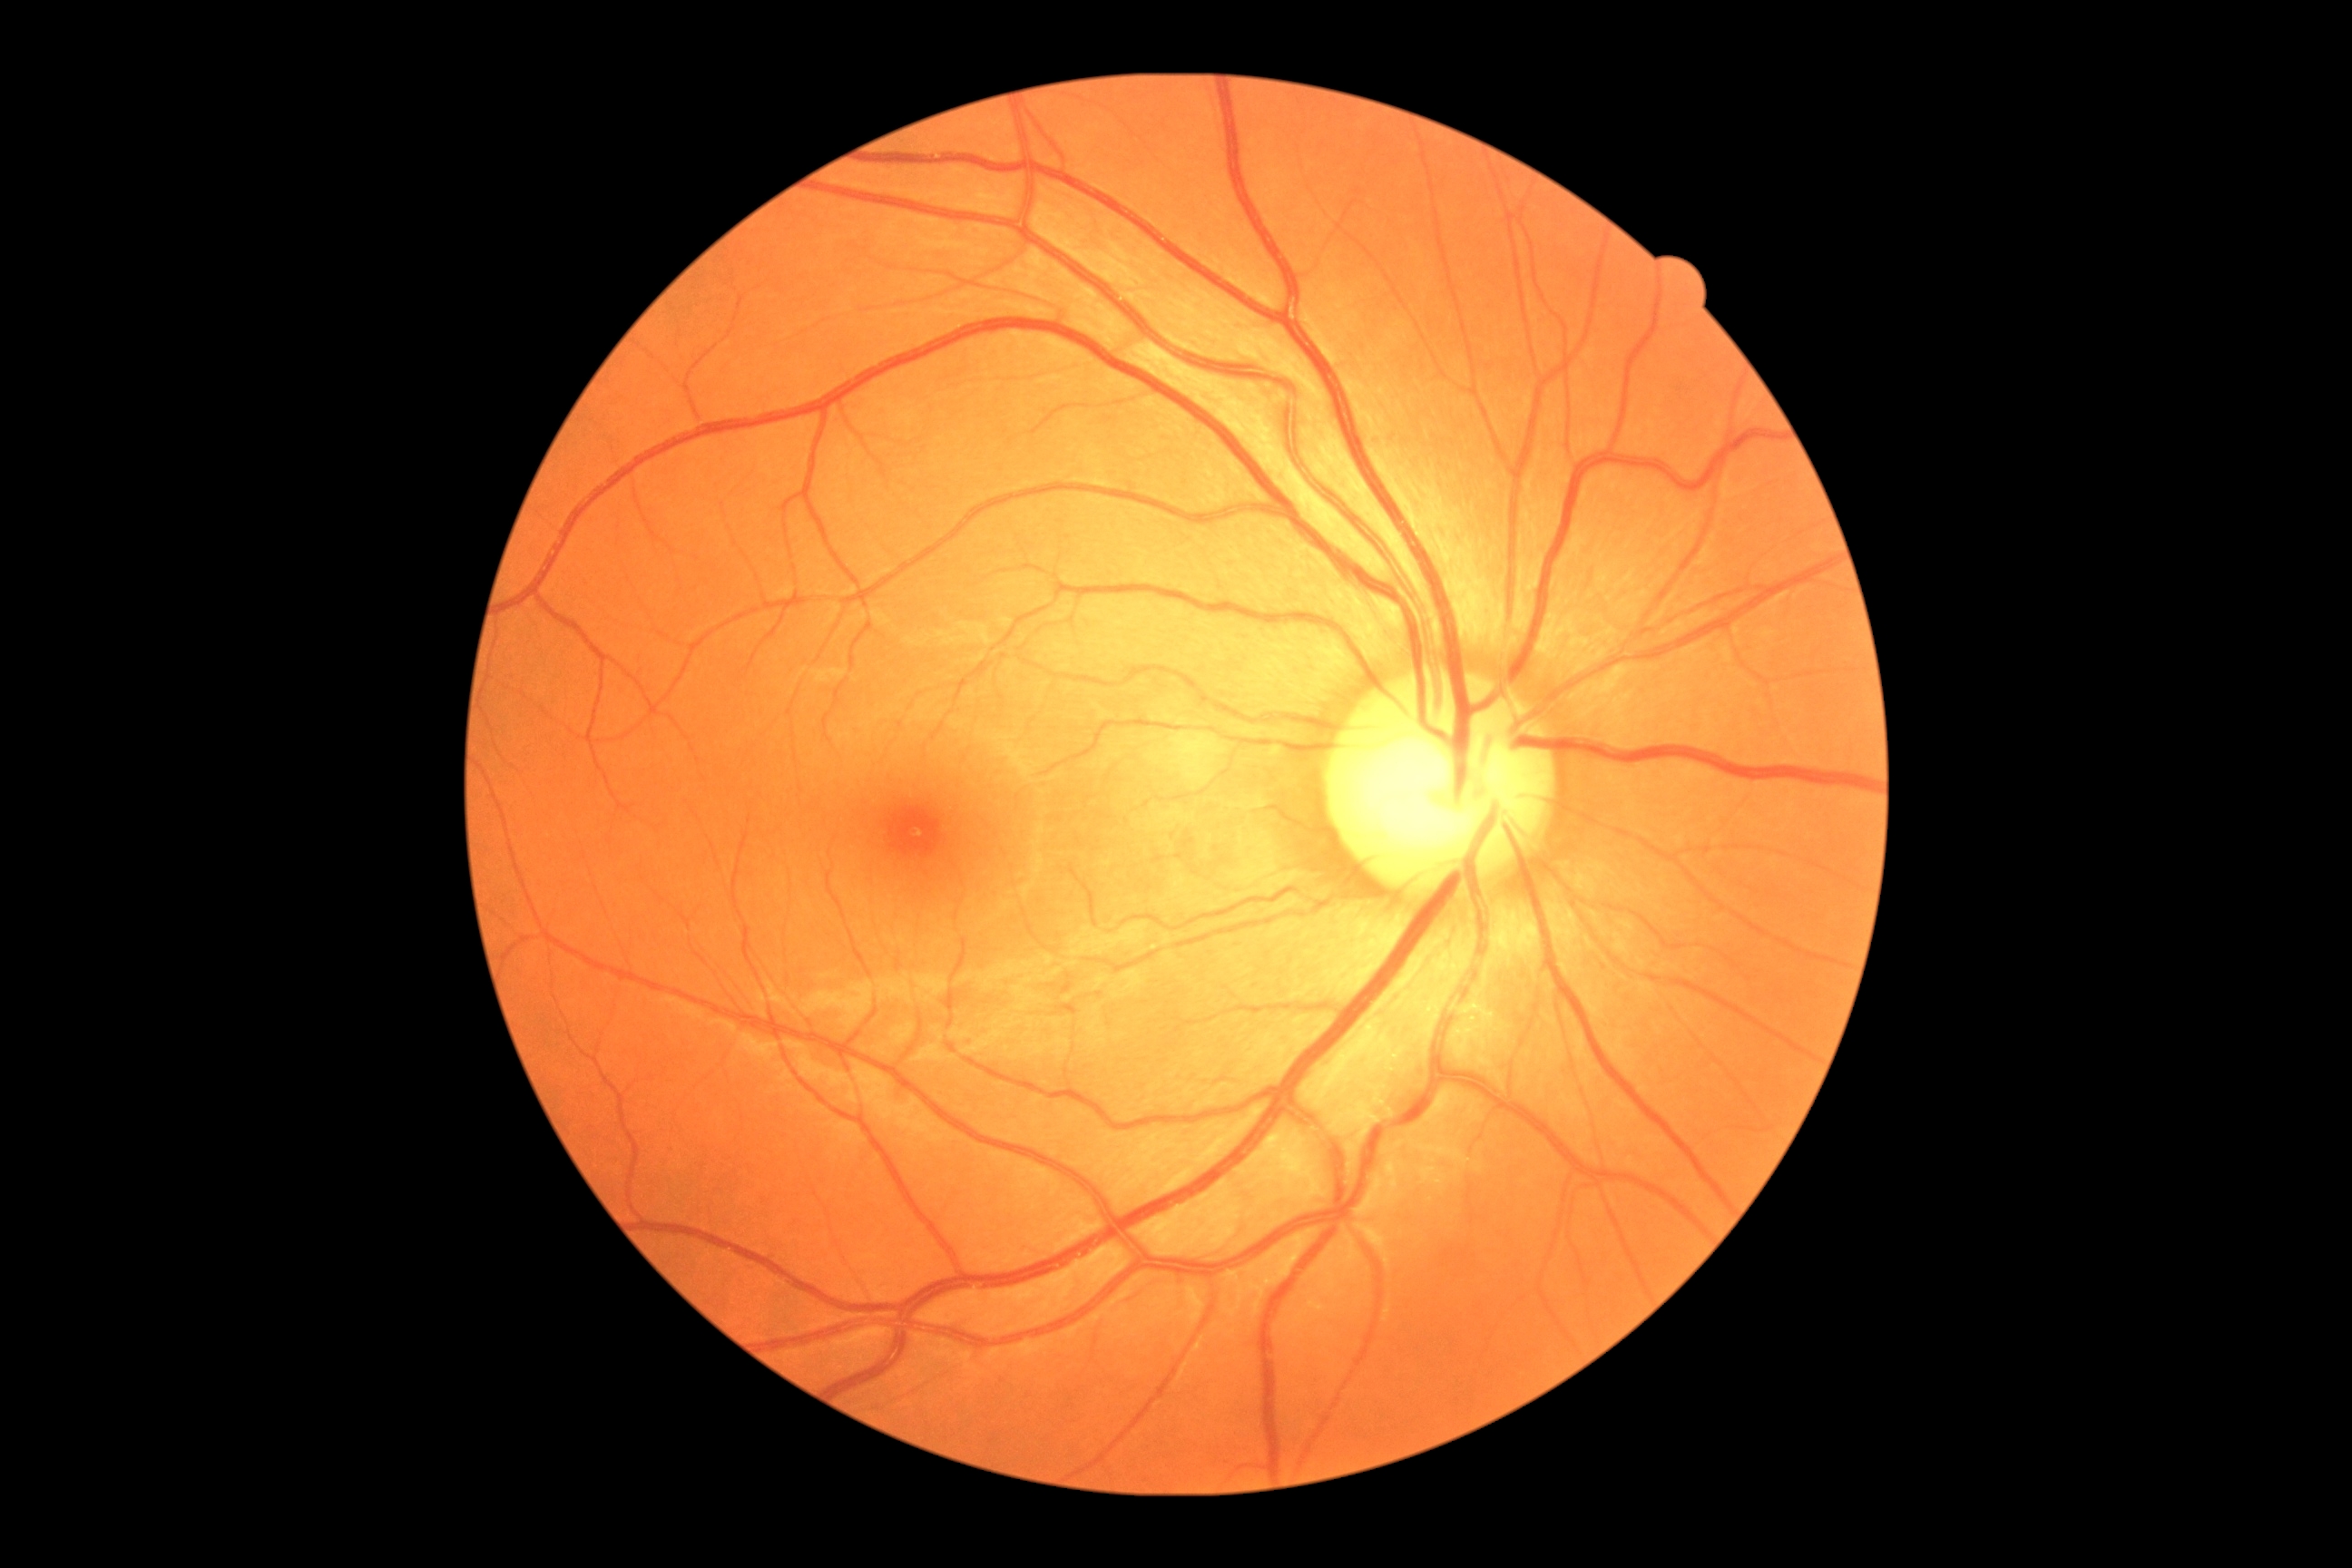 retinopathy = 0/4